Natus RetCam Envision, 130° FOV; image size 1440x1080; pediatric wide-field fundus photograph.
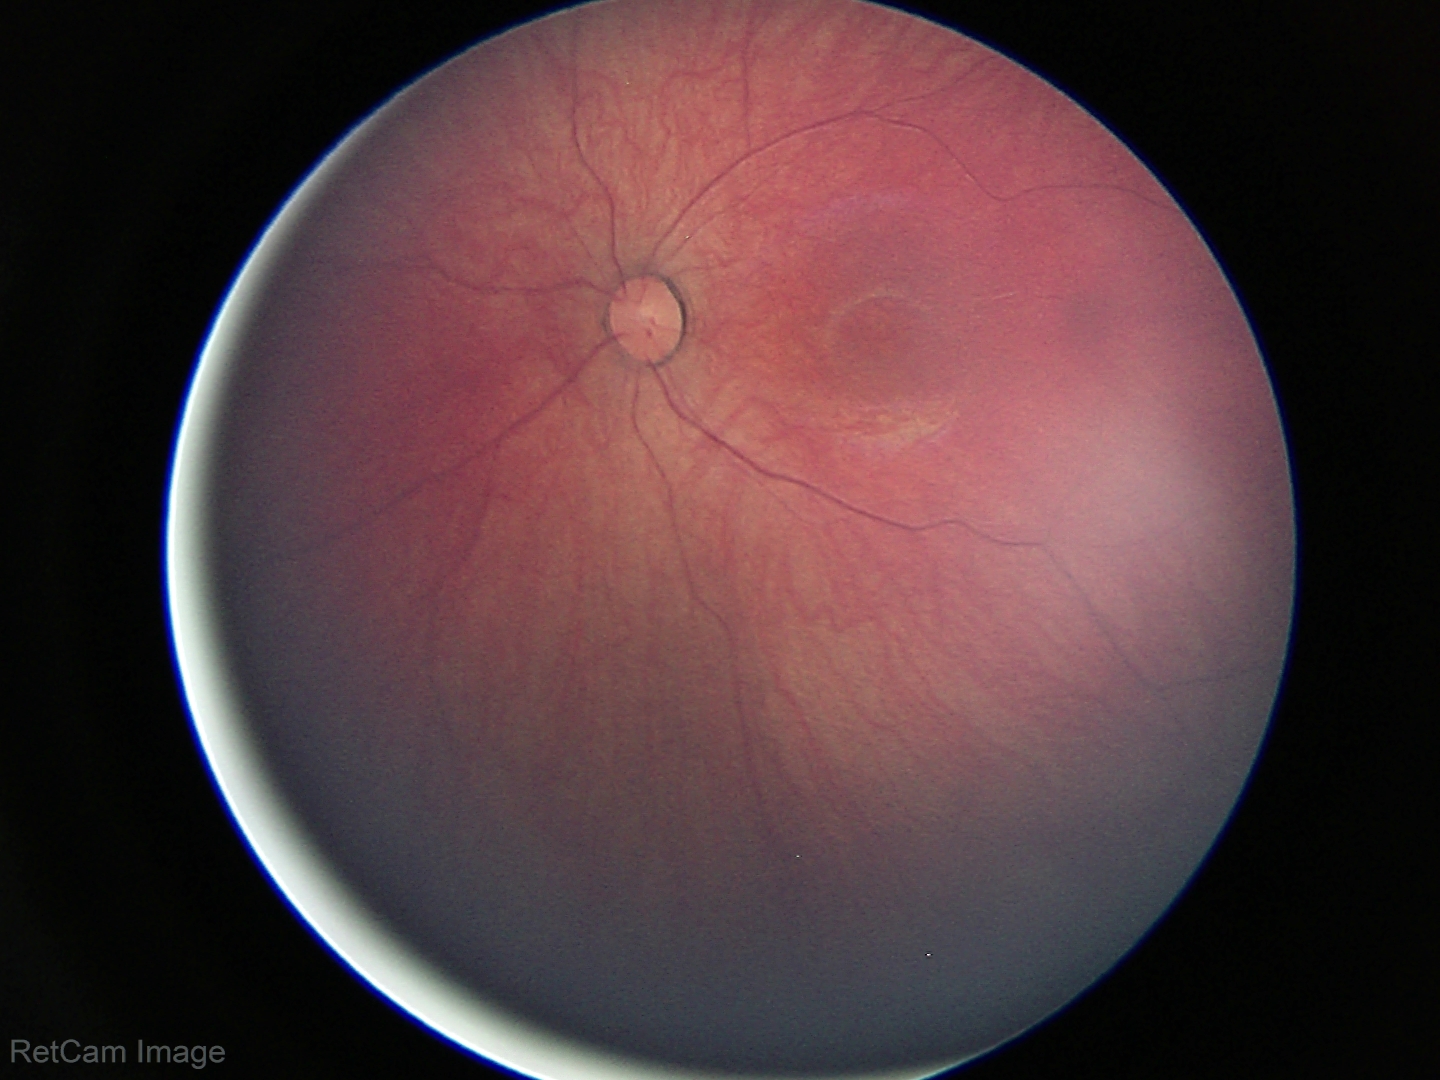 Screening examination with no abnormal retinal findings.